1932 by 1932 pixels.
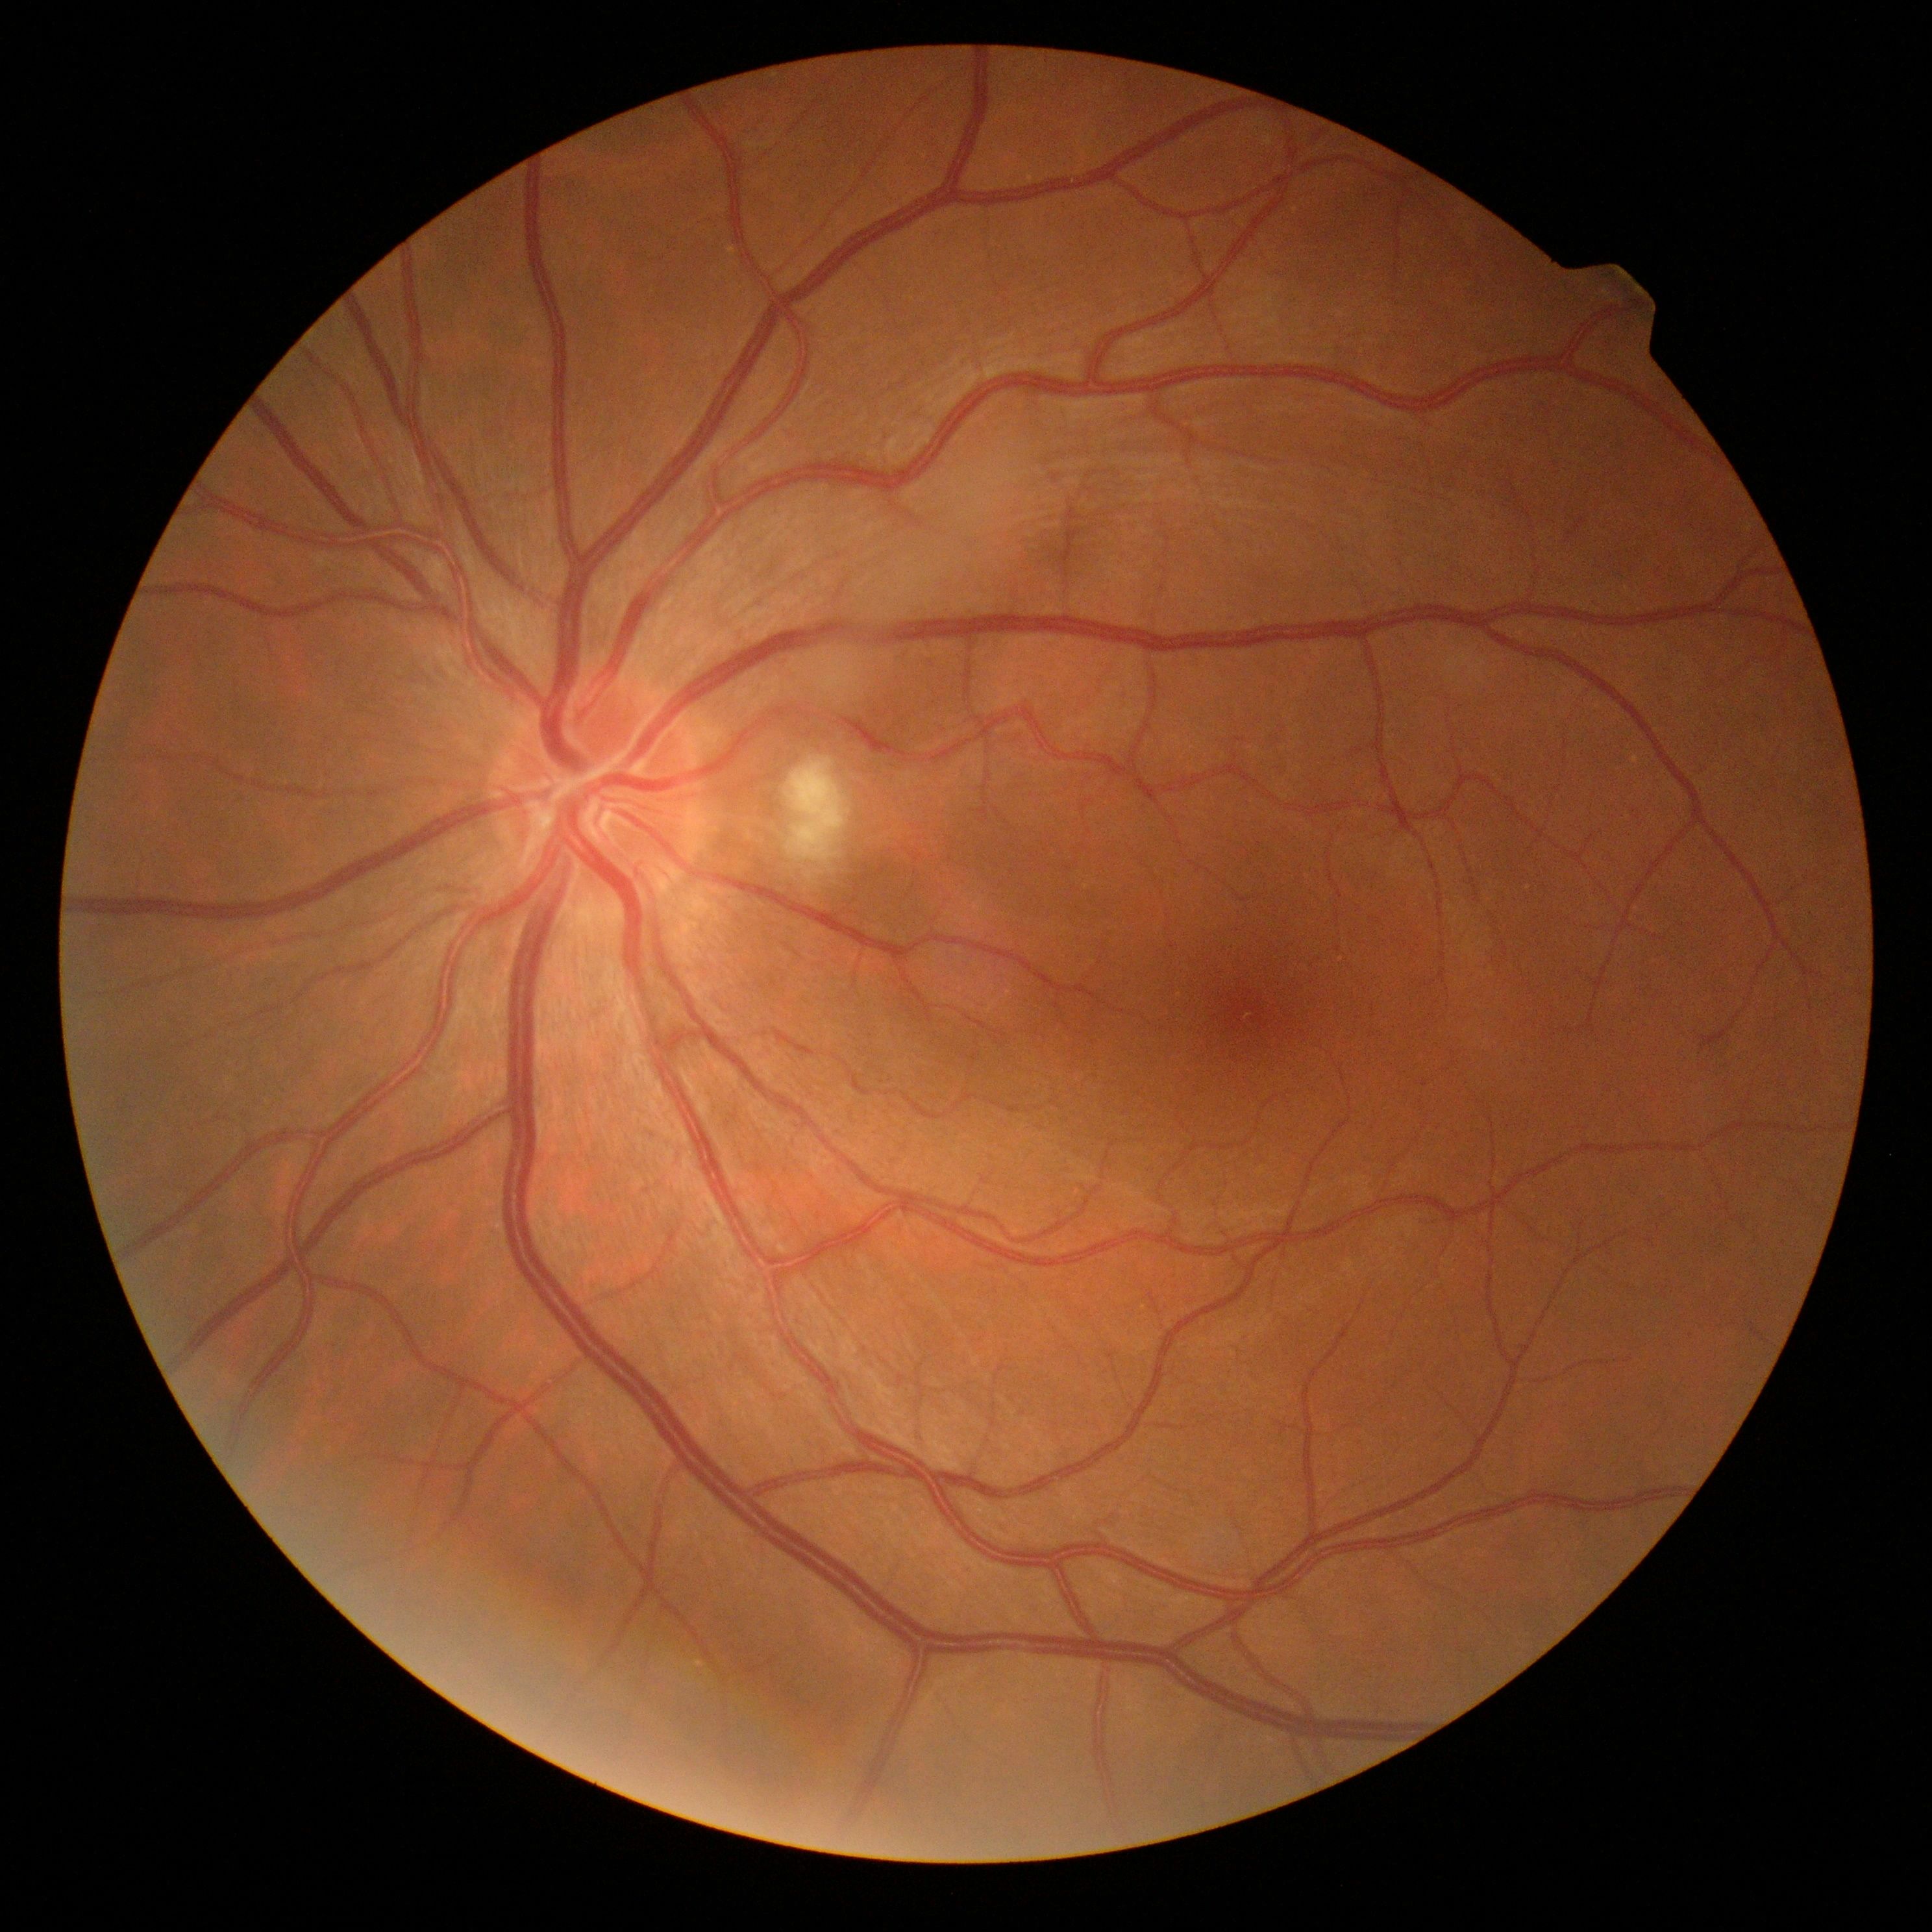
Retinopathy is 2
* microaneurysms: none detected
* hard exudates: none detected
* soft exudates: box(790, 758, 852, 871)
* hemorrhages: none detected